NIDEK AFC-230 · 45° FOV · posterior pole photograph · Davis DR grading.
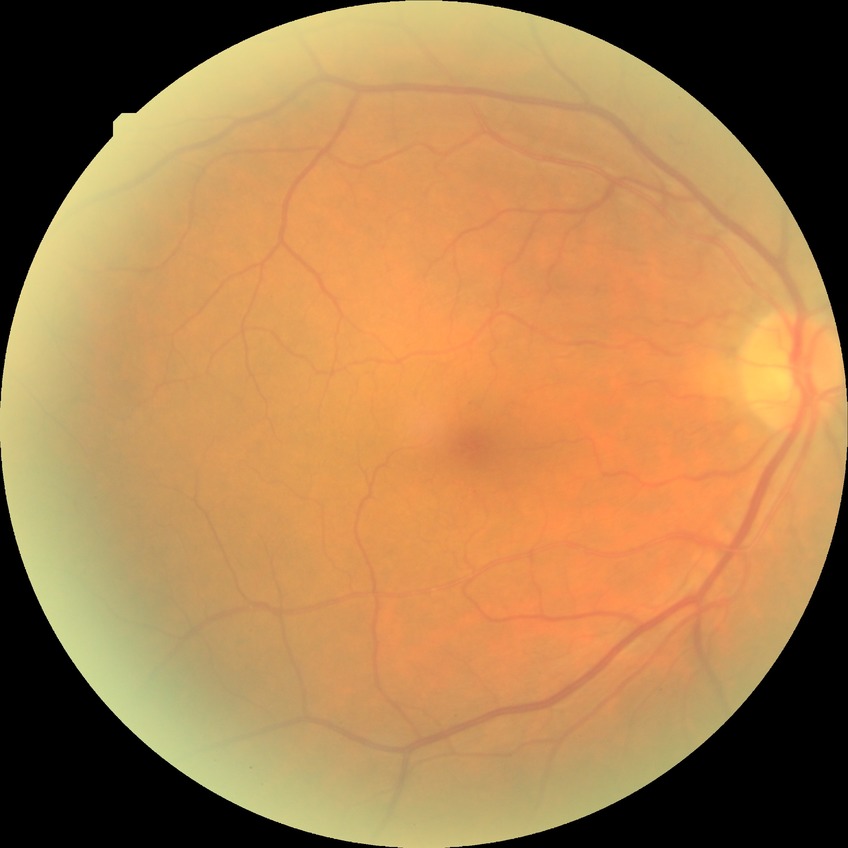 Diabetic retinopathy (DR) is no diabetic retinopathy (NDR).